45° FOV; retinal fundus photograph; 2352 by 1568 pixels: 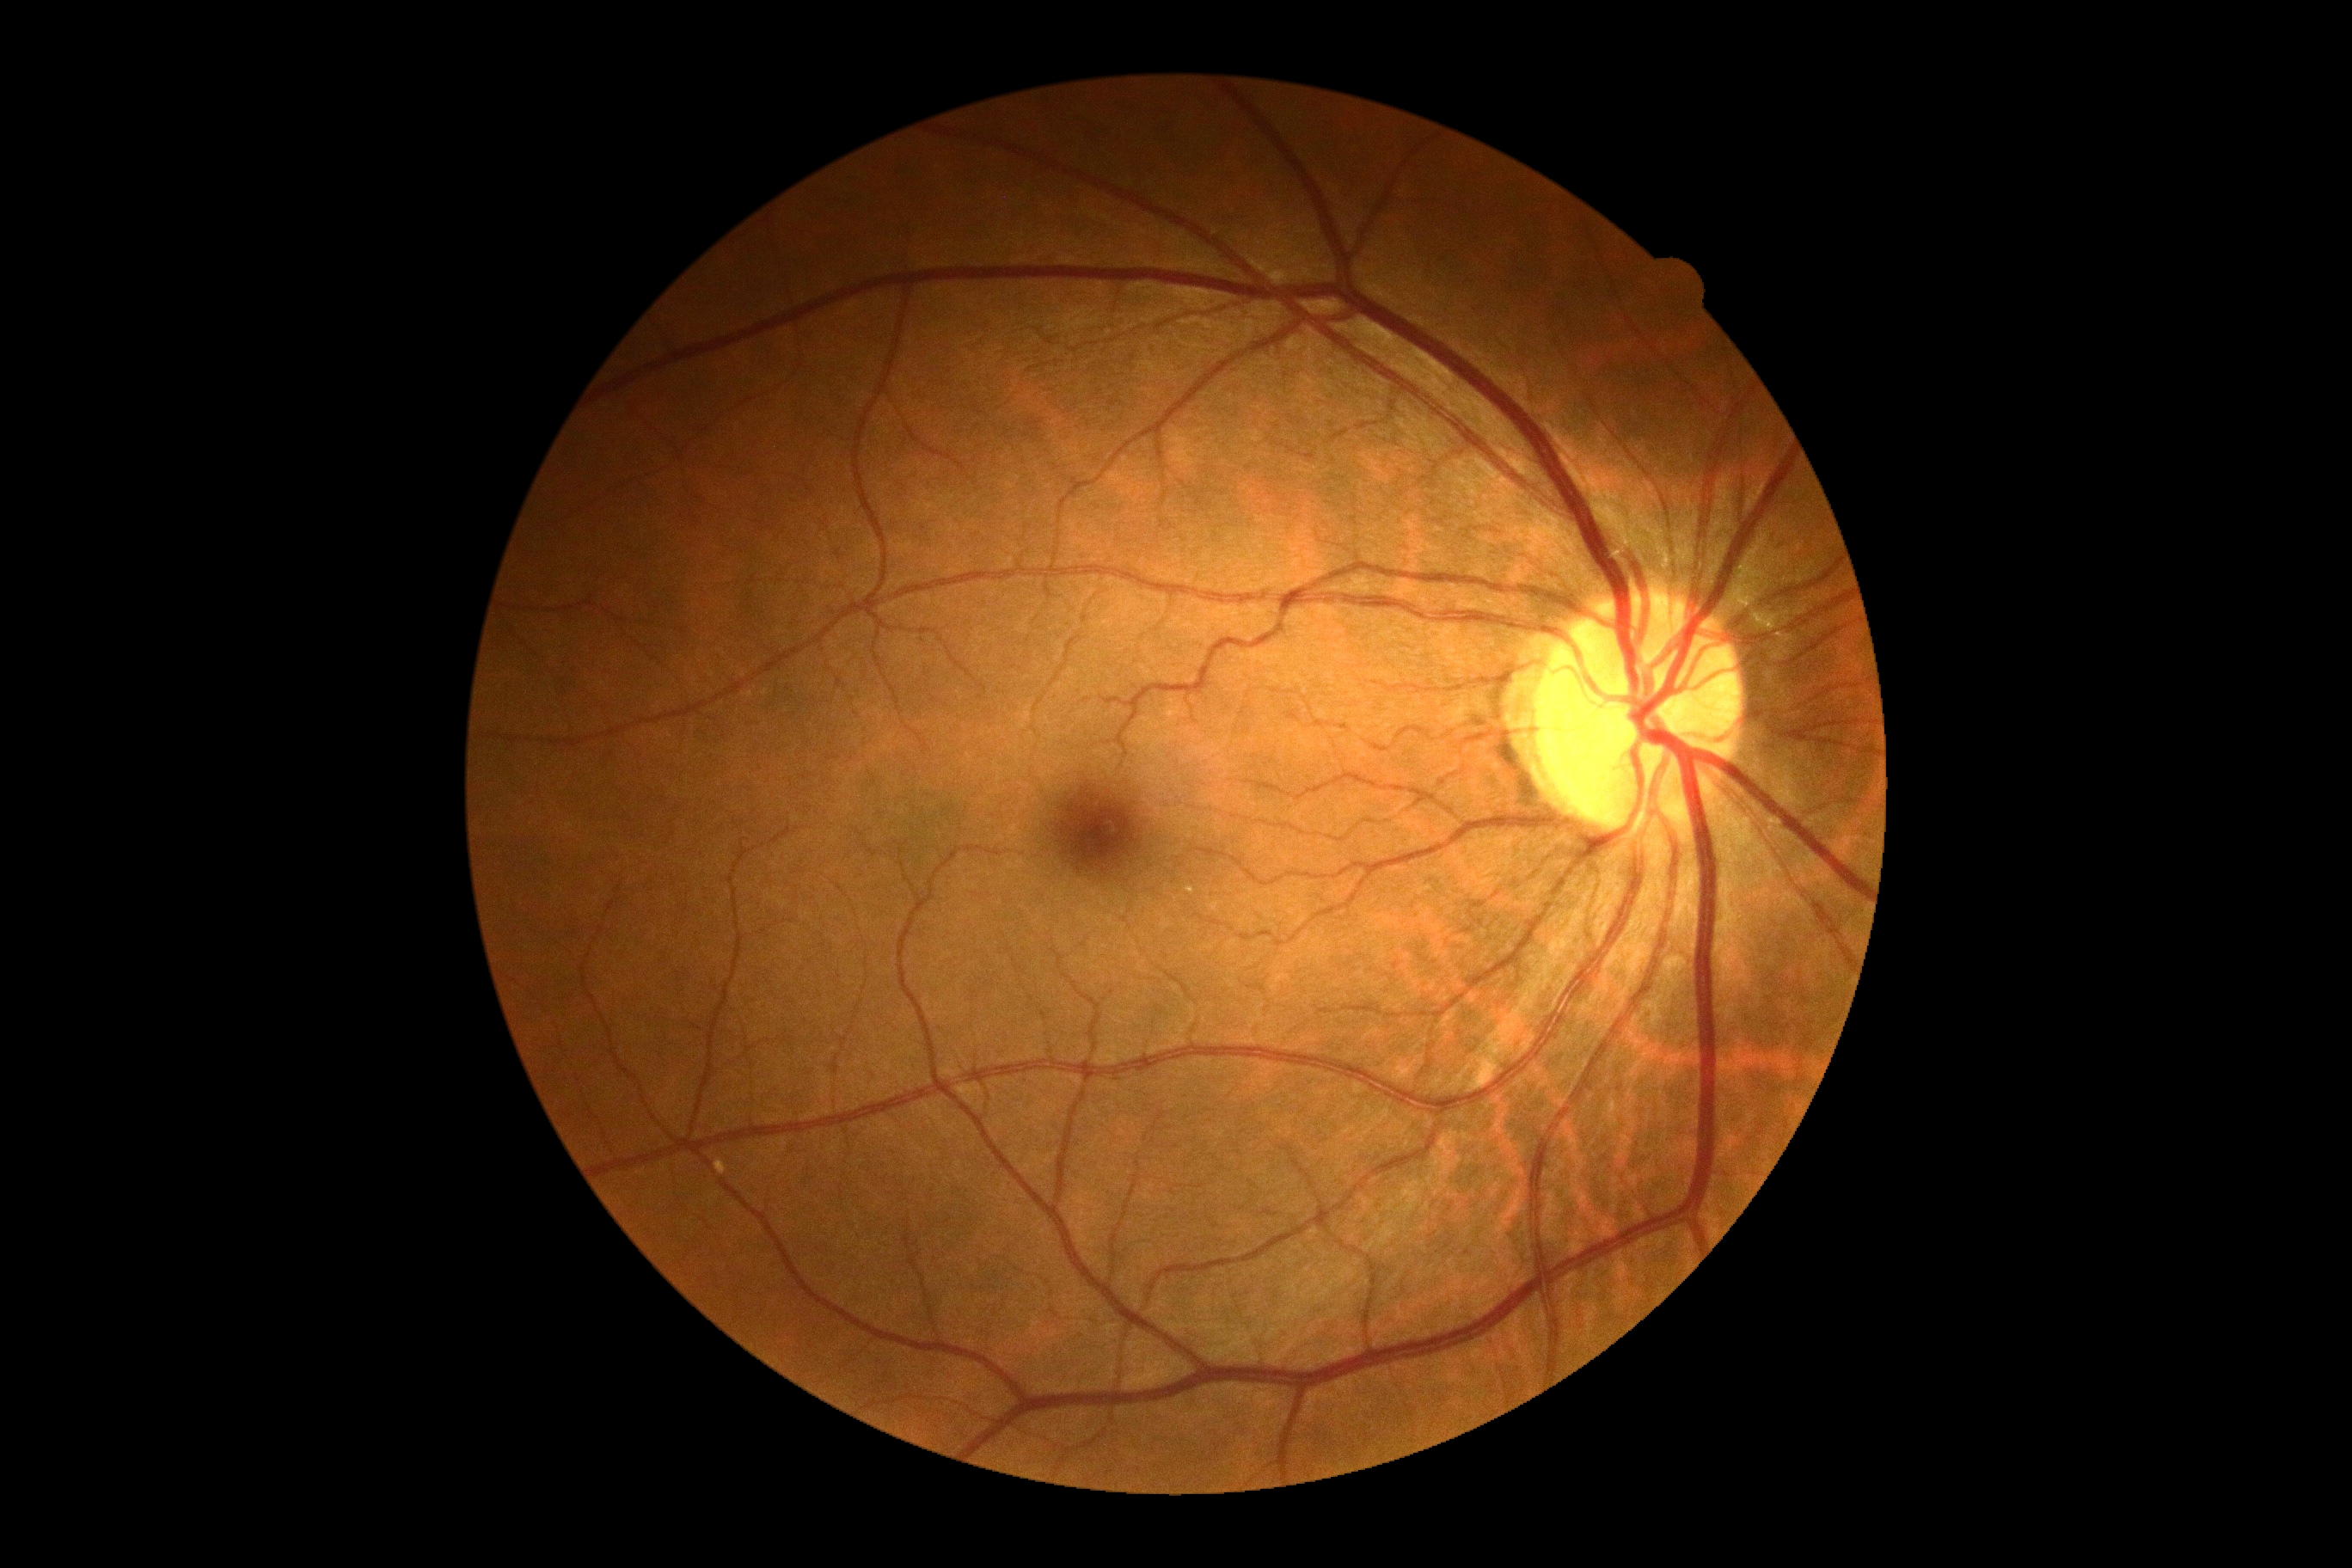 Retinopathy is 0/4 — no visible signs of diabetic retinopathy.